Graded on the modified Davis scale: 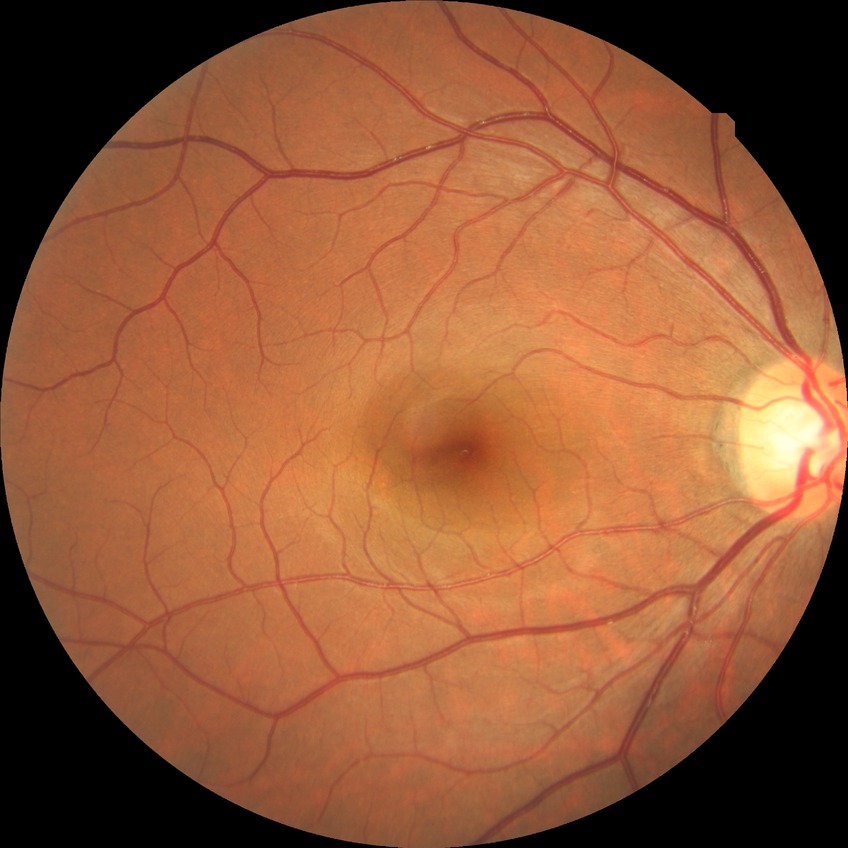 modified Davis grading: no diabetic retinopathy.